Nonmydriatic.
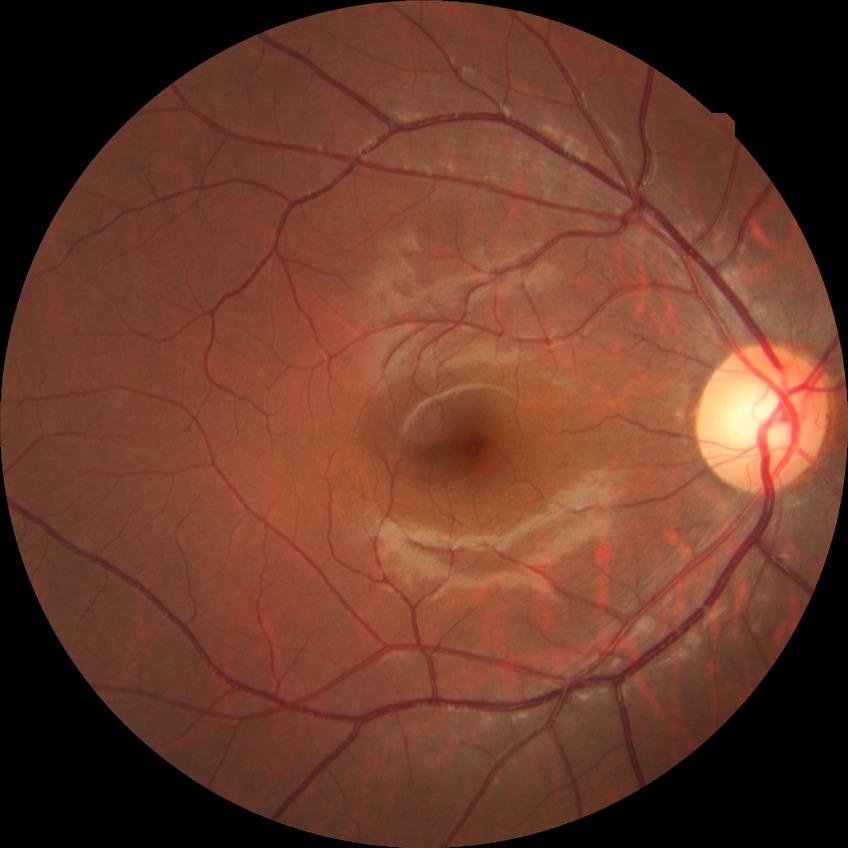

Diabetic retinopathy (DR): no diabetic retinopathy (NDR).